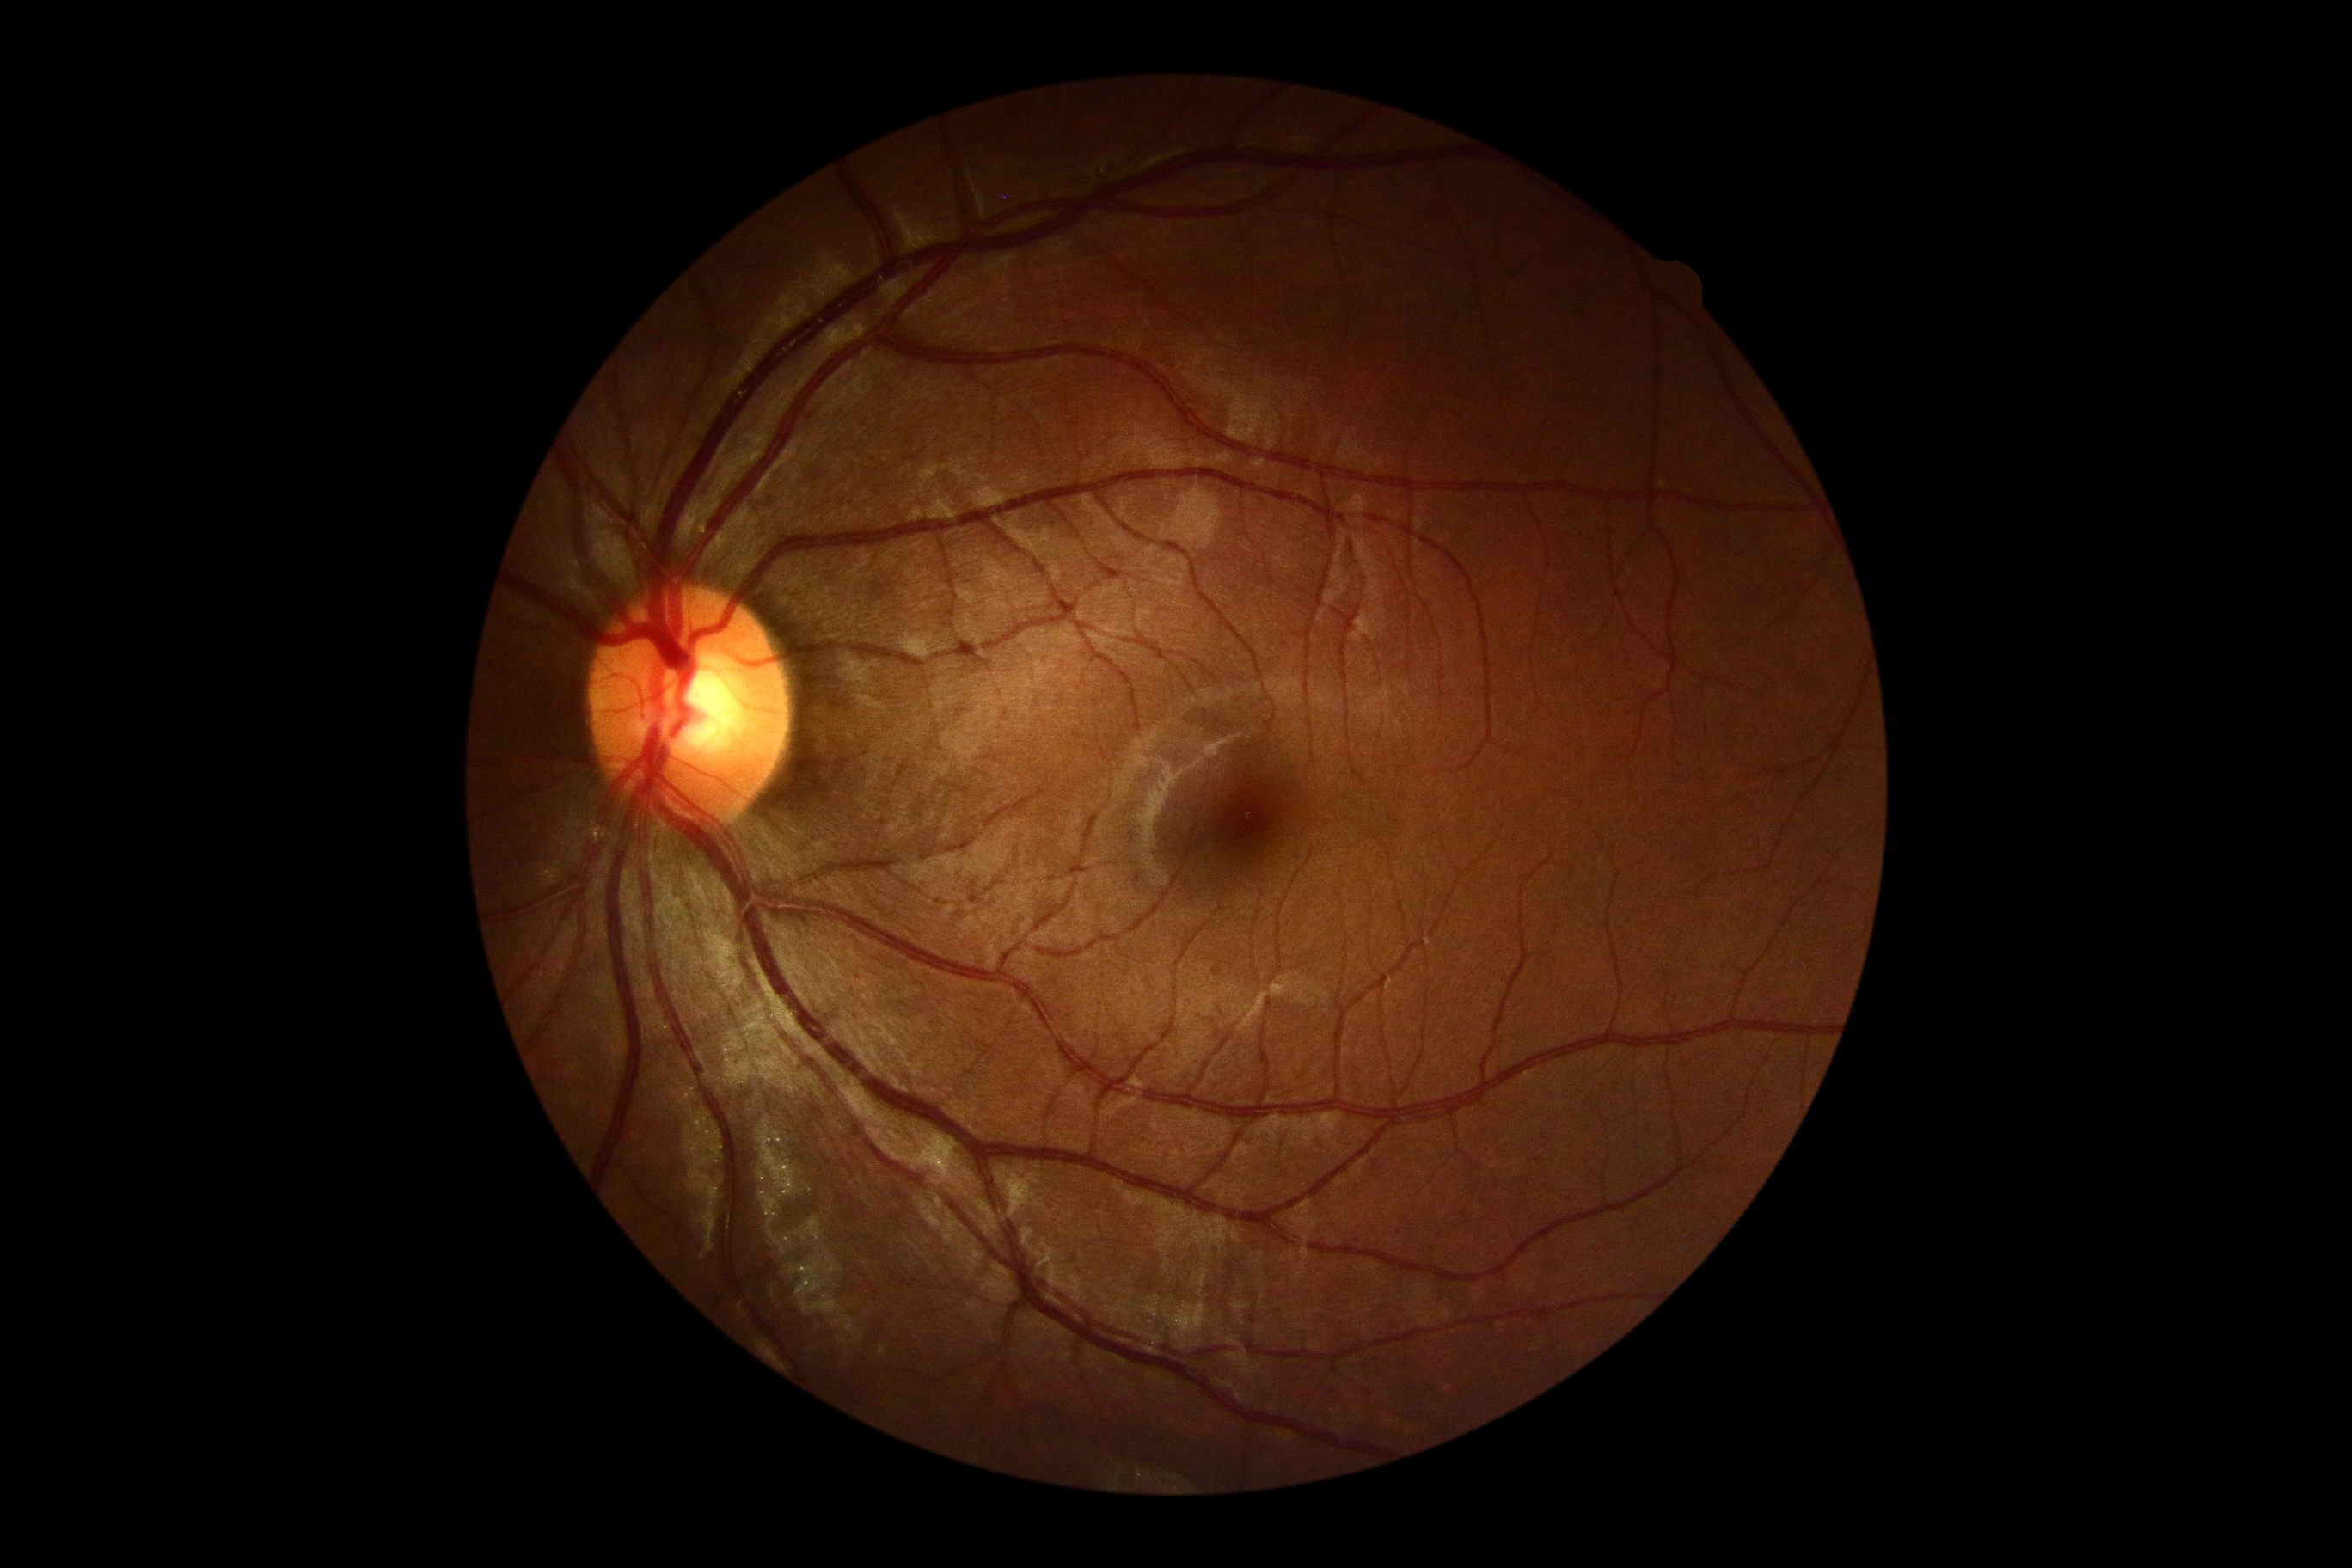
Diabetic retinopathy grade is no apparent diabetic retinopathy (0) — no visible signs of diabetic retinopathy.